Camera: Topcon TRC · optic disc region of a color fundus photo:
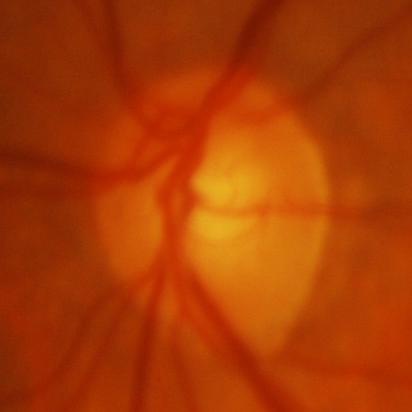

Glaucomatous optic neuropathy.